Pediatric wide-field fundus photograph; captured with the Clarity RetCam 3 (130° field of view); 640x480: 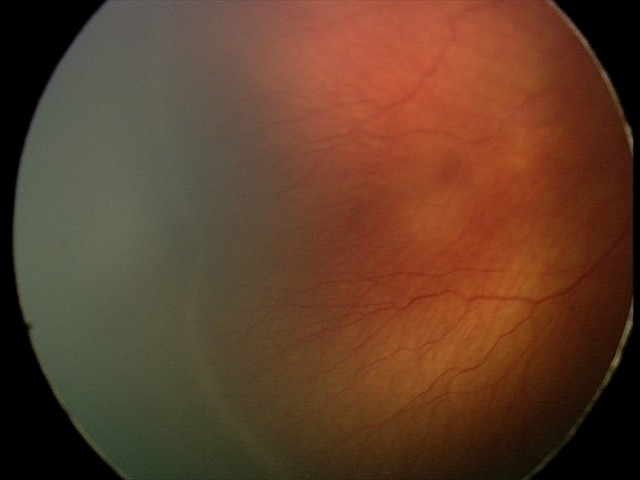
Impression: ROP stage 2 — ridge with height and width at the demarcation line.